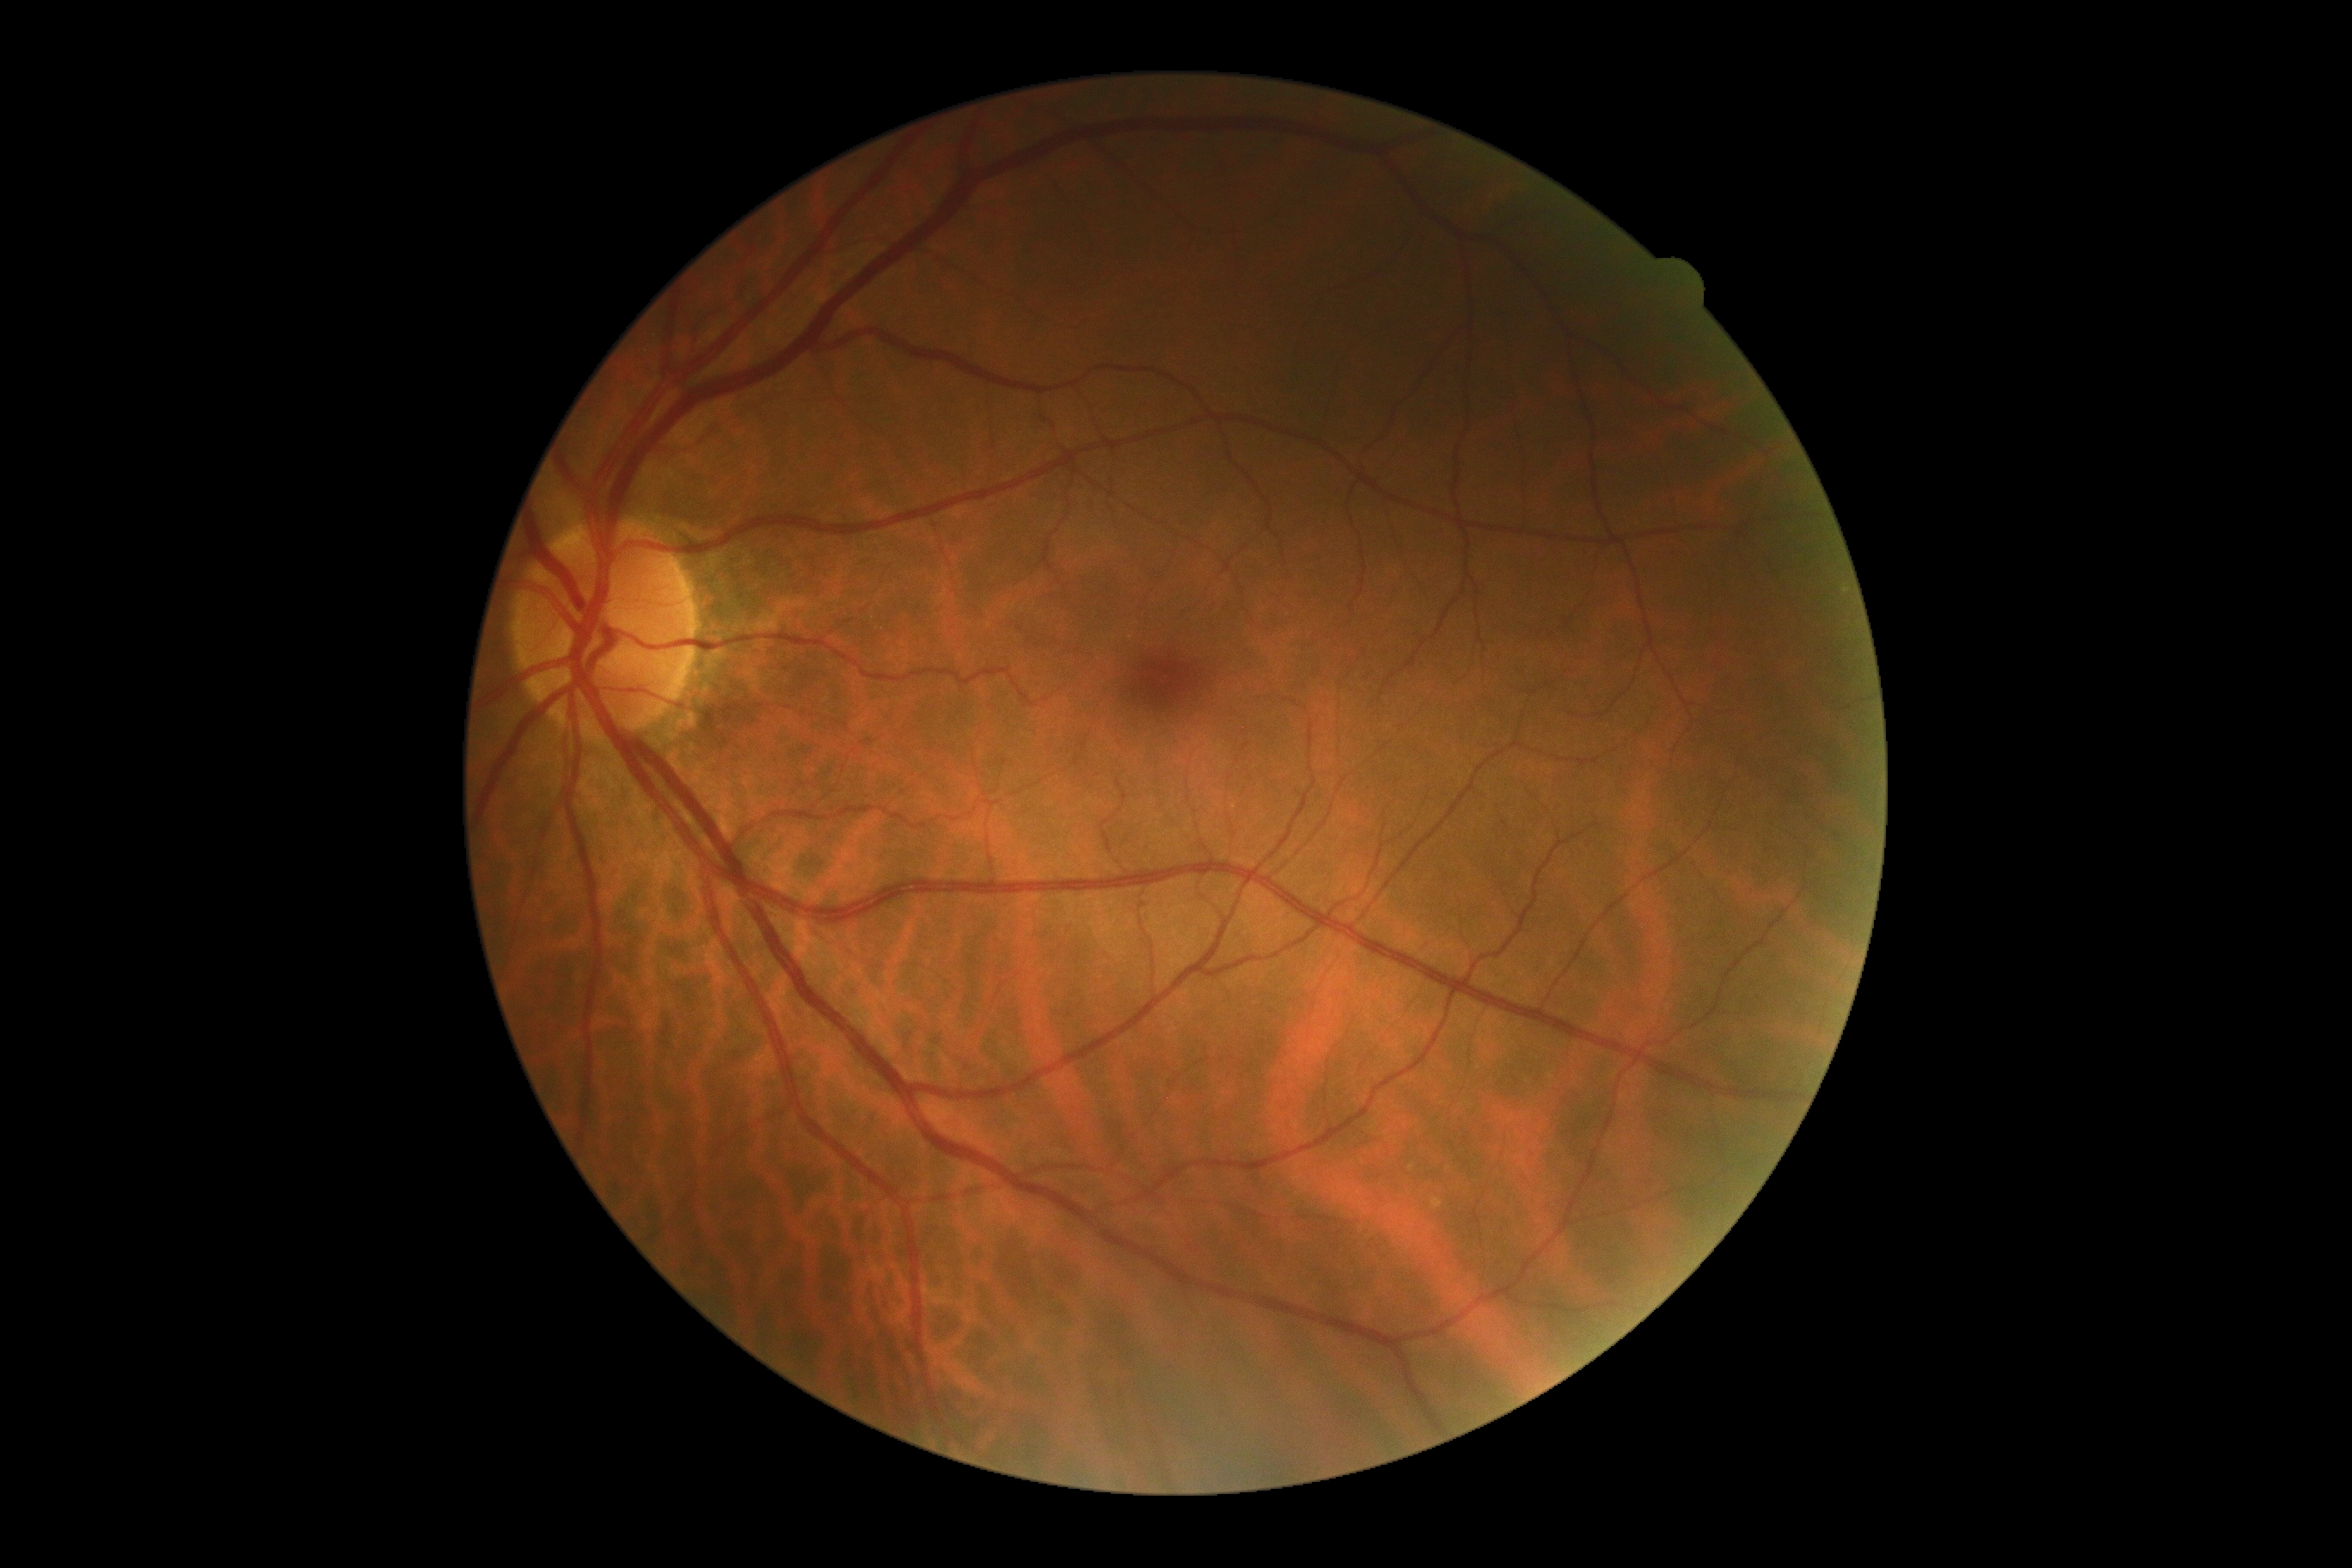 Findings:
- diabetic retinopathy grade: no apparent diabetic retinopathy (0)
- DR impression: negative for DR